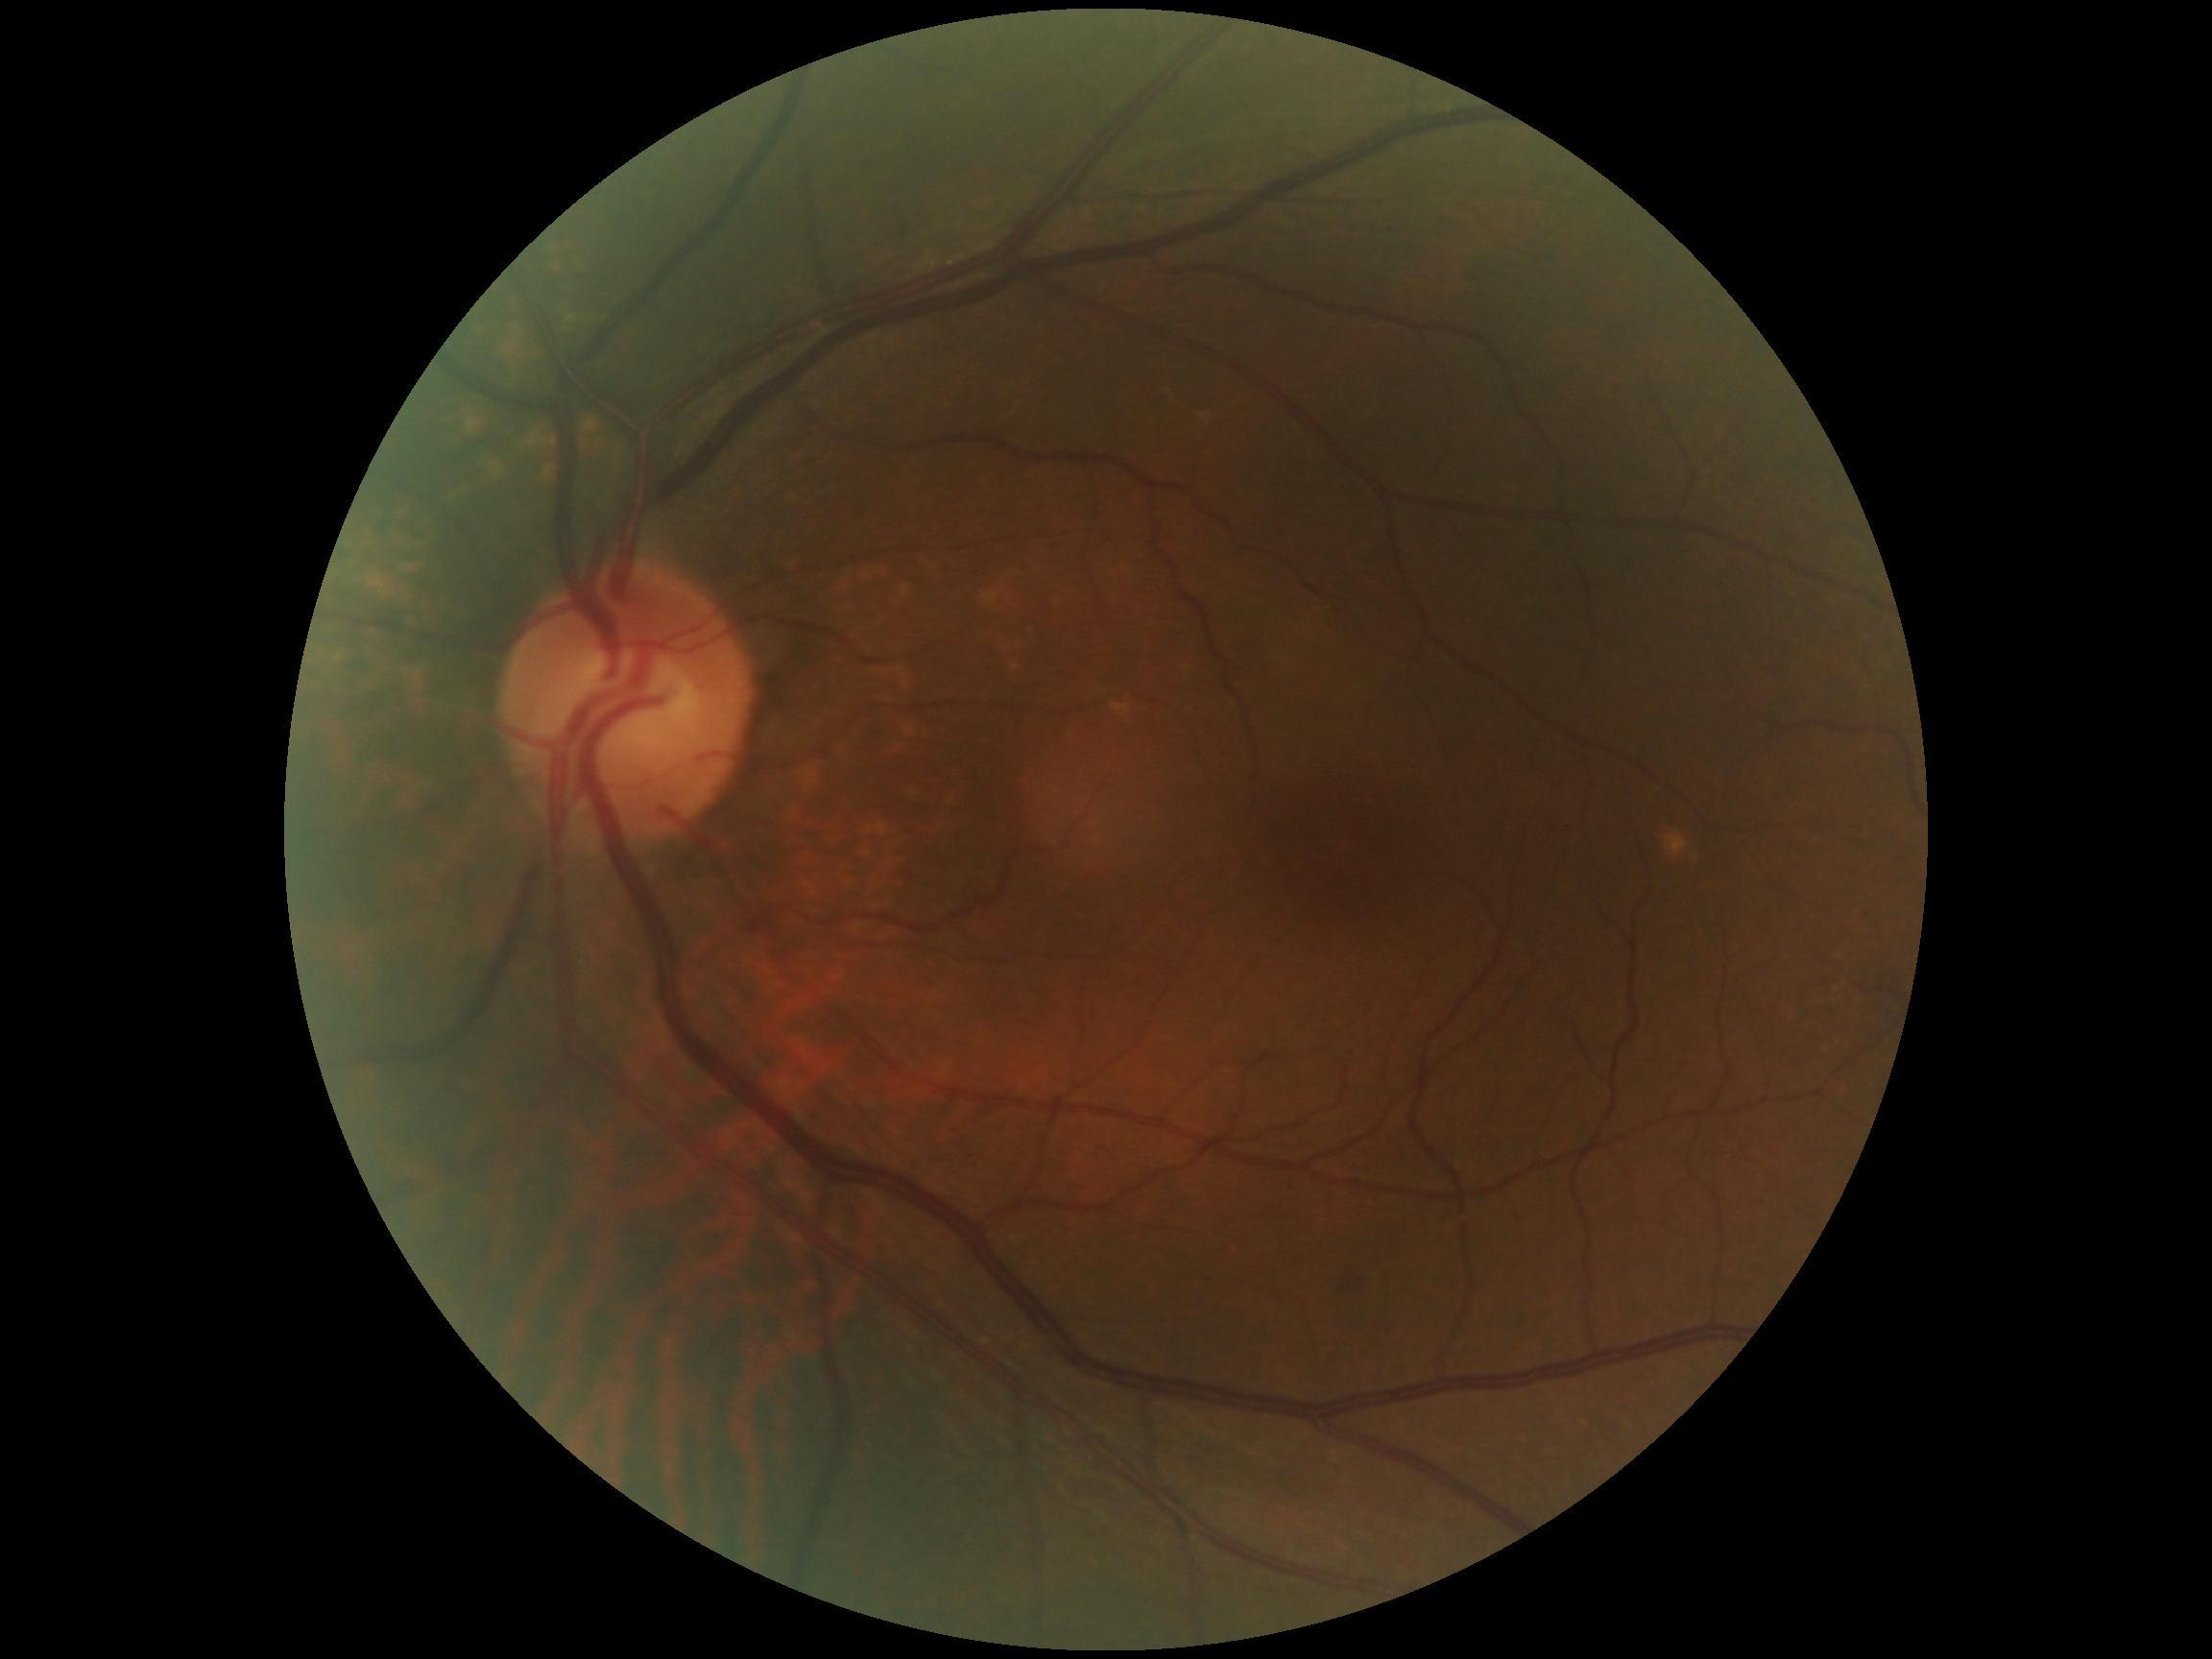 diabetic retinopathy = grade 2 (moderate NPDR).